Wide-field fundus photograph of an infant; image size 1440x1080; camera: Natus RetCam Envision (130° FOV).
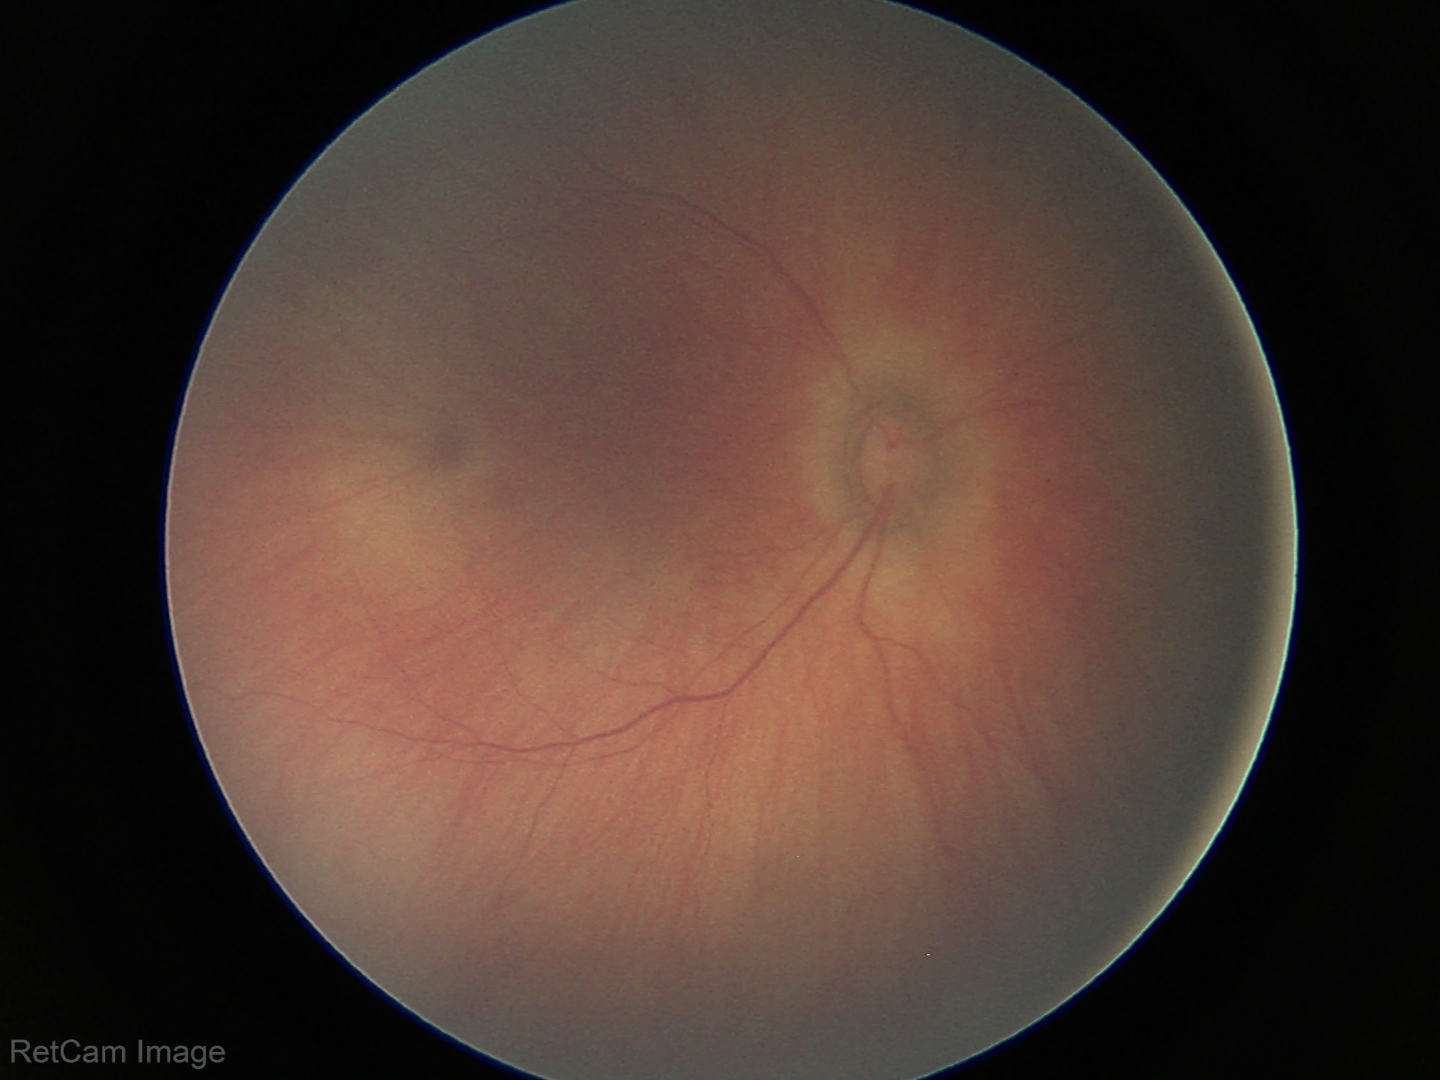

Physiological retinal appearance for postconceptual age.